Color fundus photograph, 1659 x 2212 pixels, Remidio Fundus on Phone (FOP) camera: 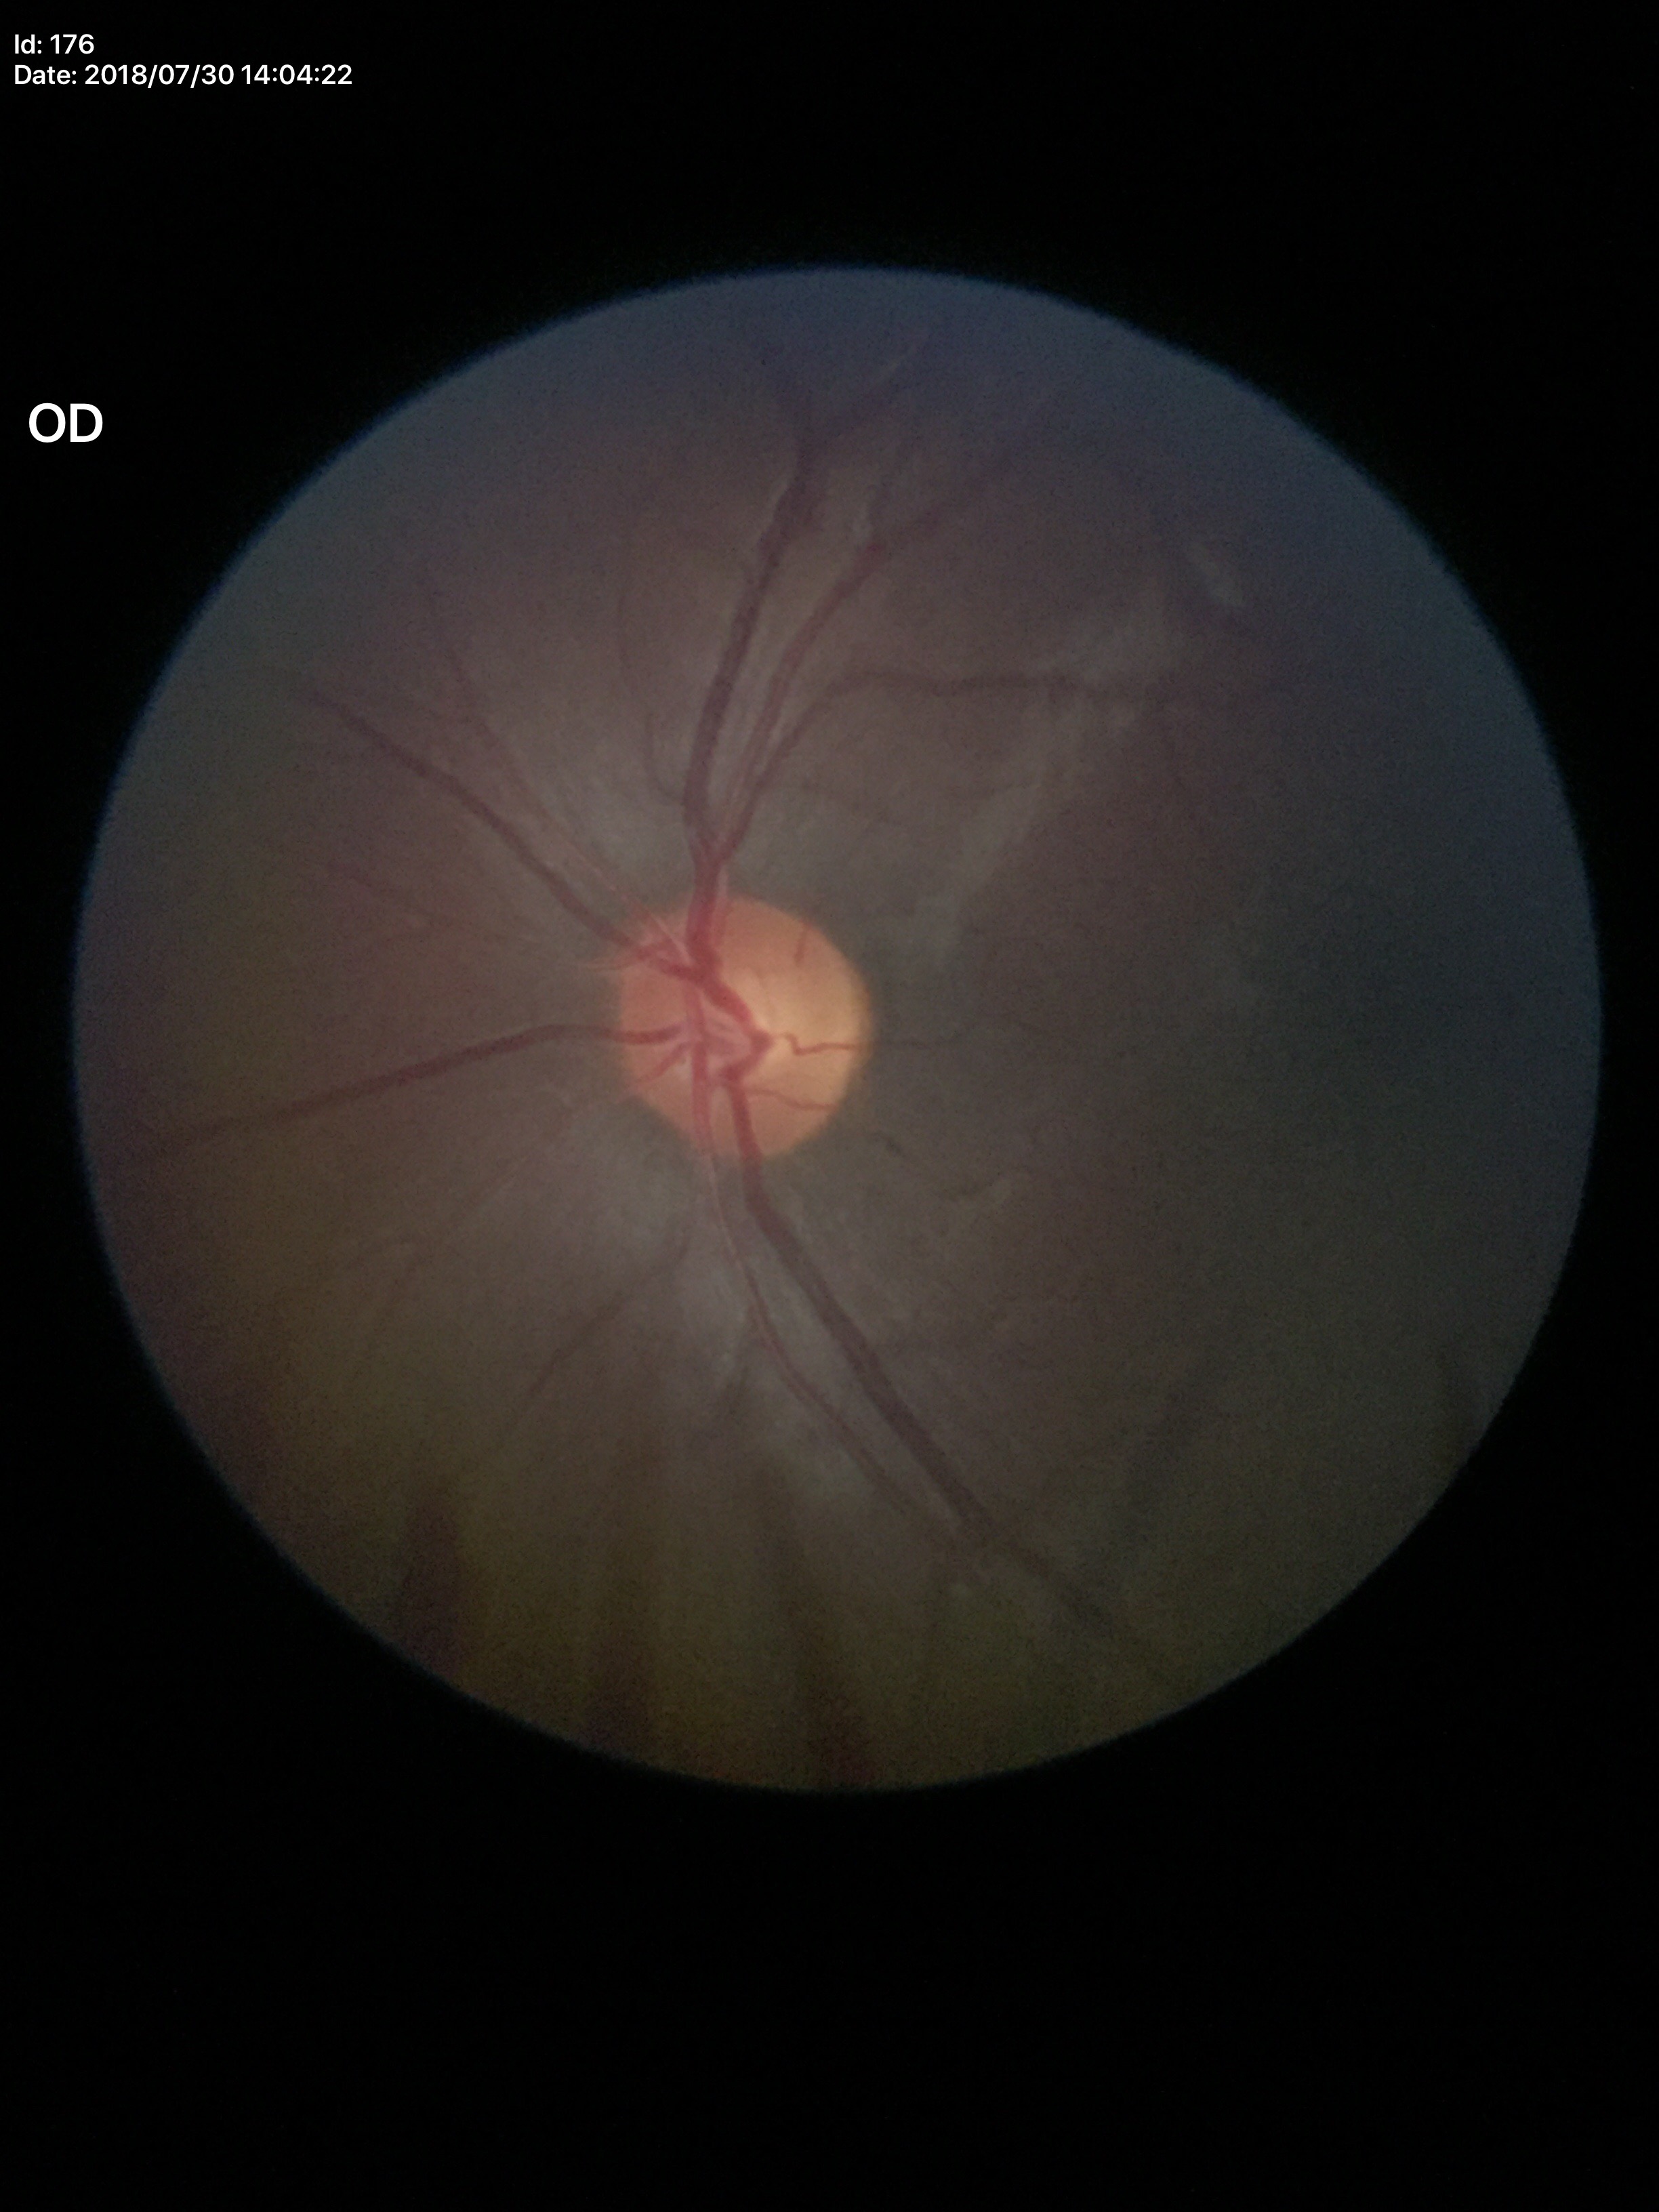 Glaucoma evaluation = no suspicious findings
vertical CDR (VCDR) = 0.53
horizontal C/D ratio (HCDR) = 0.51